Color fundus photograph, no pharmacologic dilation
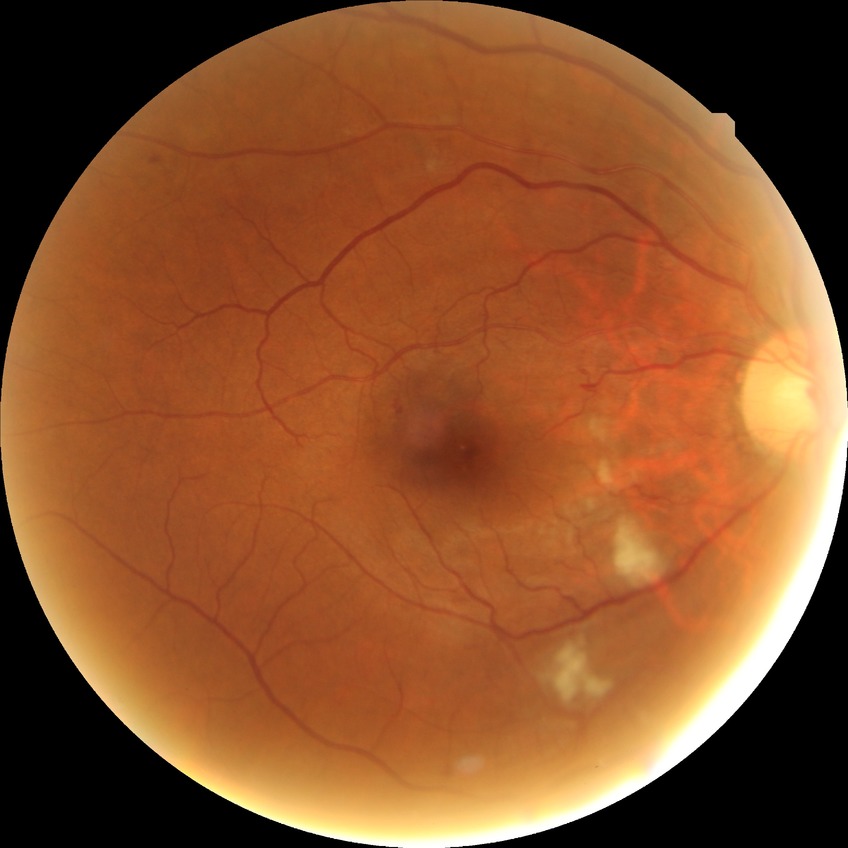 DR severity: PPDR.